Posterior pole photograph, modified Davis classification: 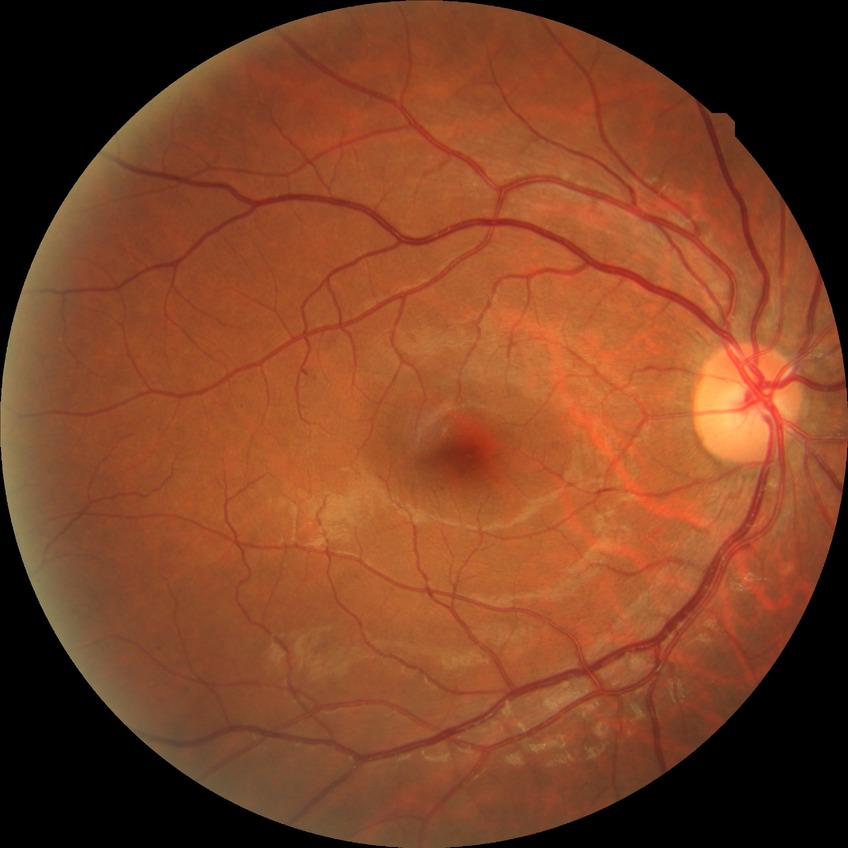 diabetic retinopathy (DR): SDR (simple diabetic retinopathy), DR class: non-proliferative diabetic retinopathy.